Patient age: 66 years. Refractive error: sphere +2.25 D, cylinder -1.25 D, axis 73°. Corneal thickness: 537 µm. Female patient.
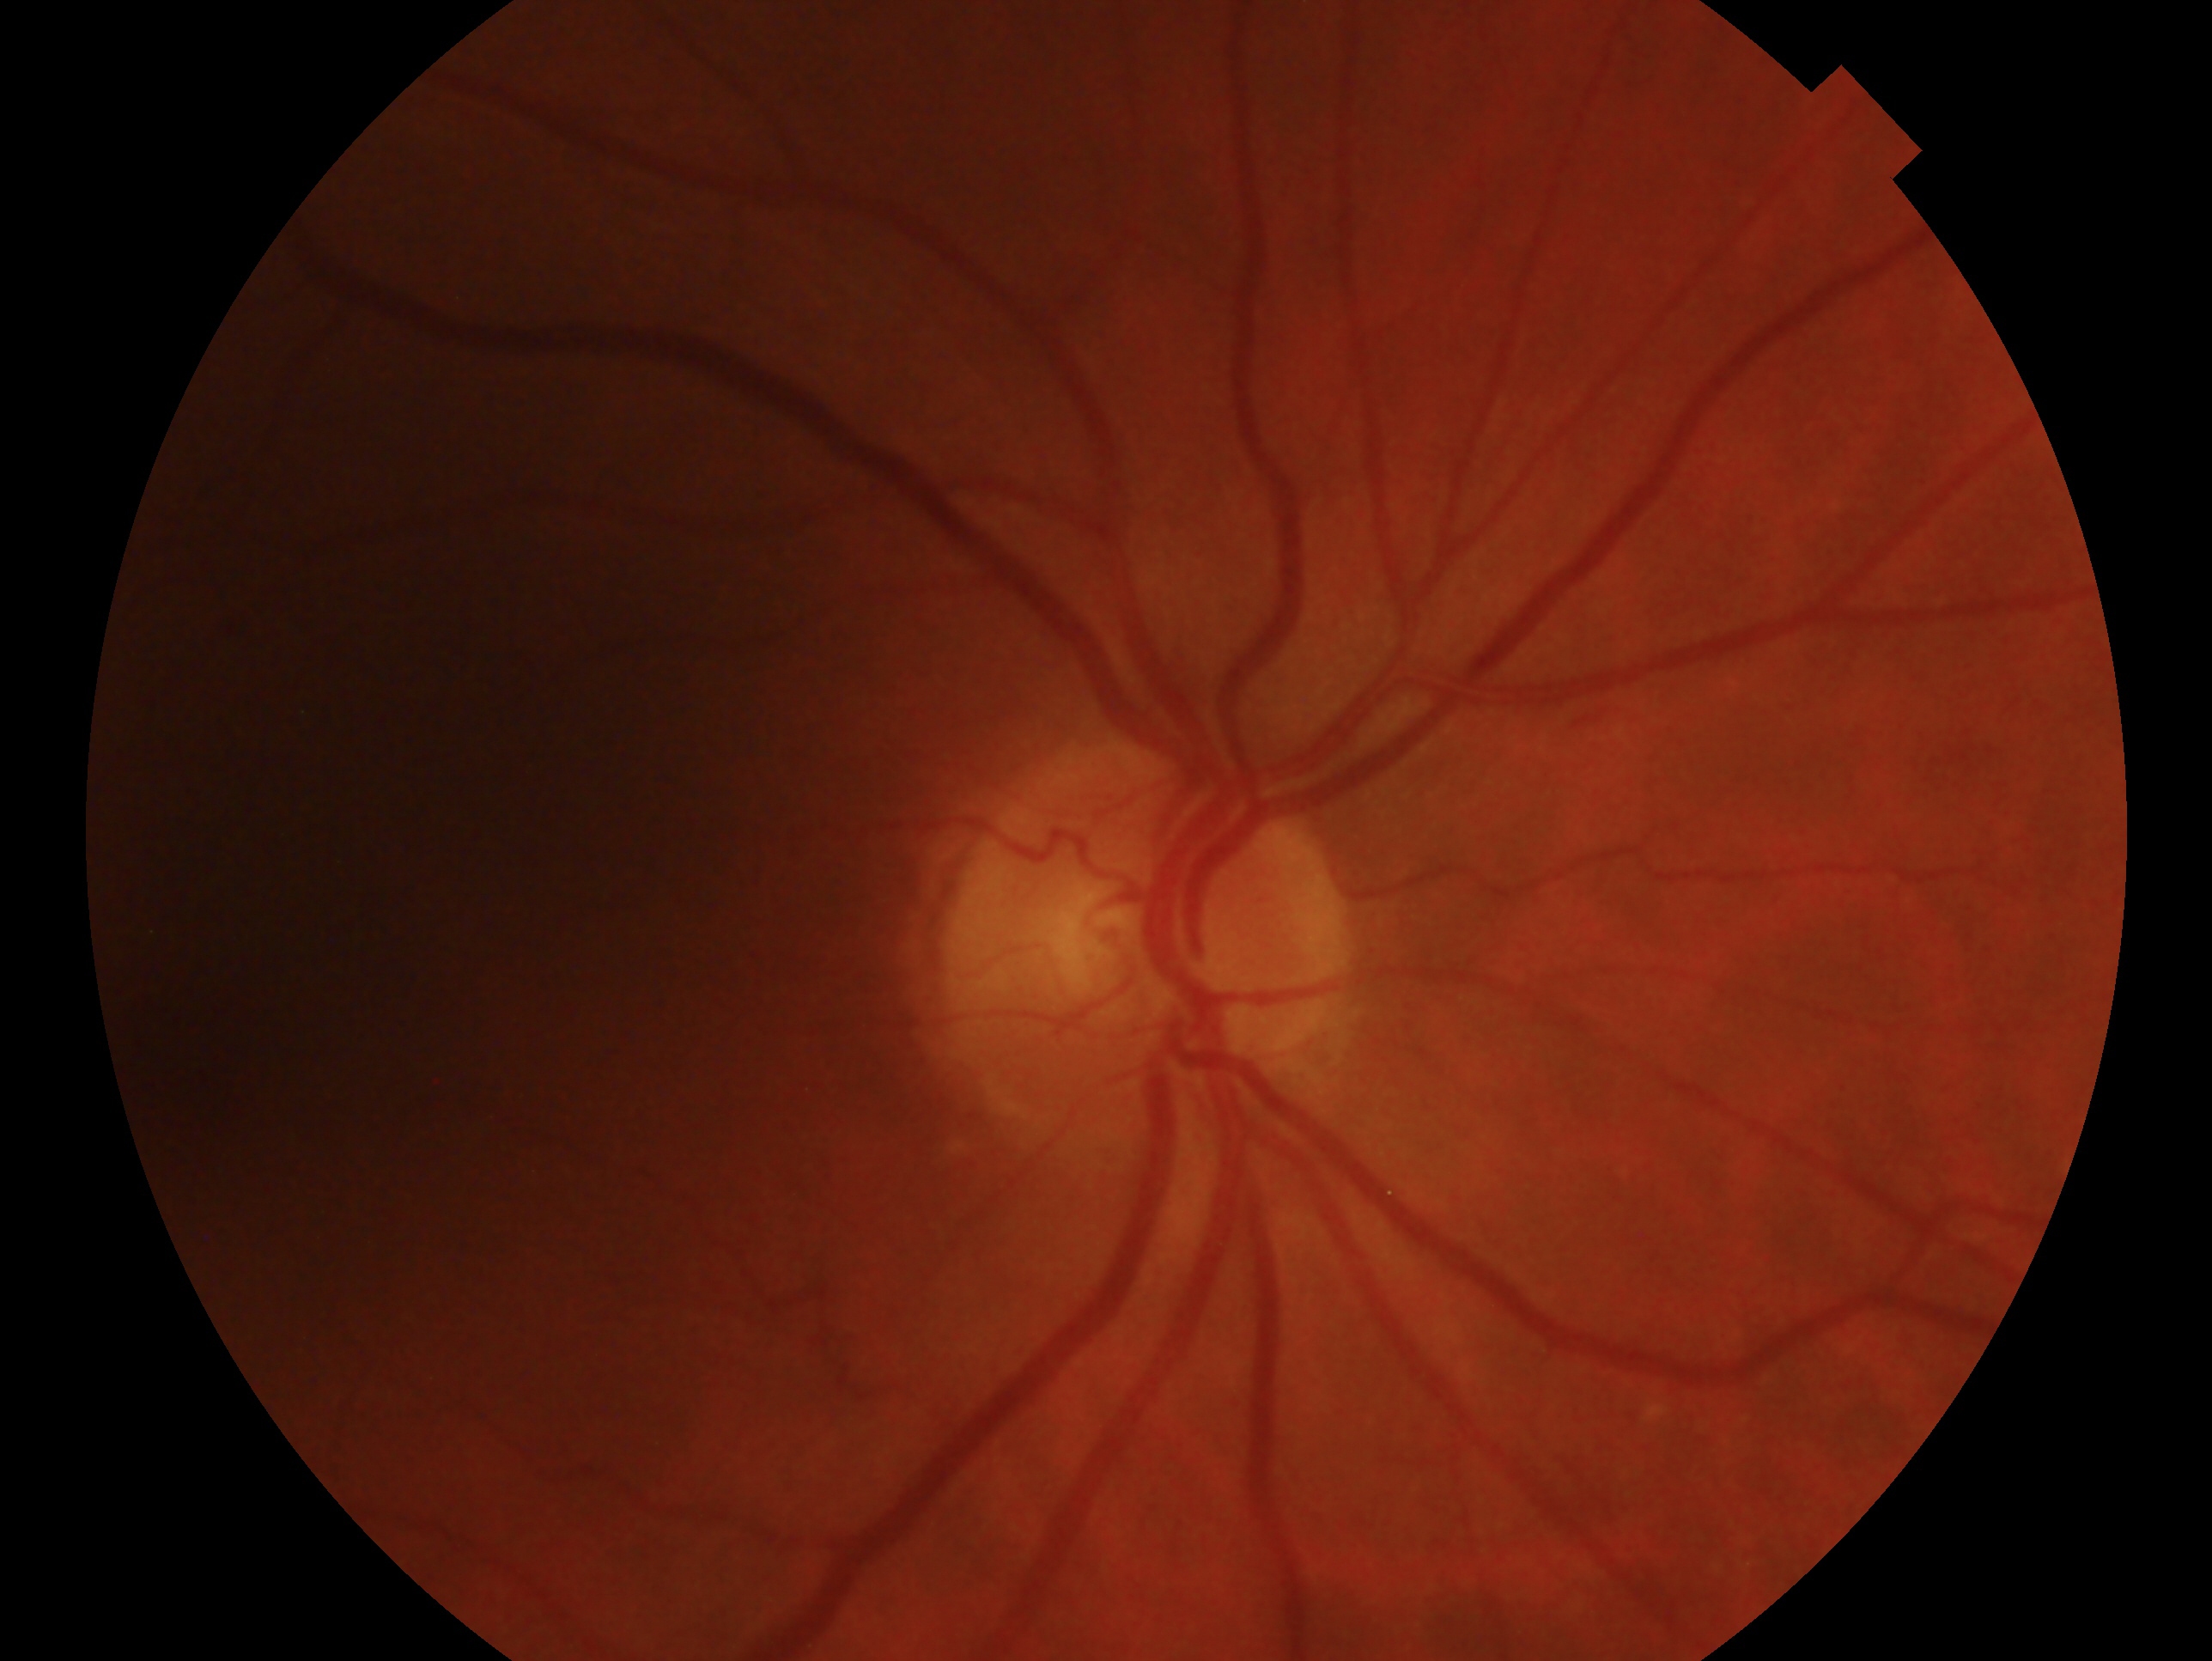 laterality: right
glaucoma diagnosis: negative for glaucoma — no clinical evidence of glaucoma in this eye